Retinal fundus photograph, acquired with a NIDEK AFC-230, 45 degree fundus photograph, nonmydriatic, 848x848: 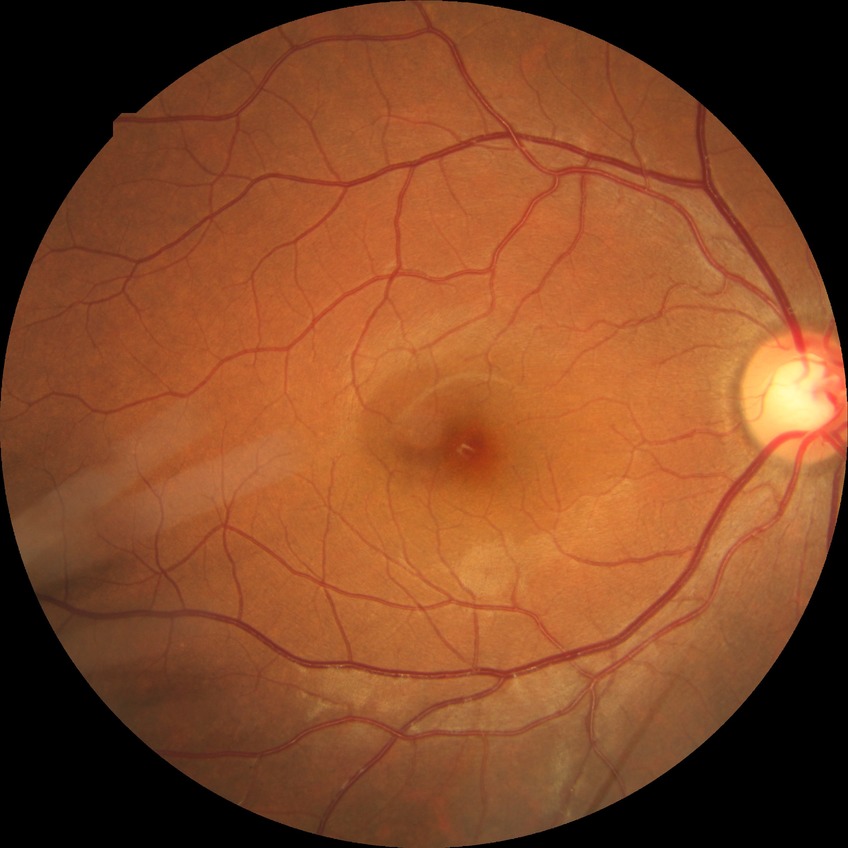

Retinopathy stage is no diabetic retinopathy.